45° FOV.
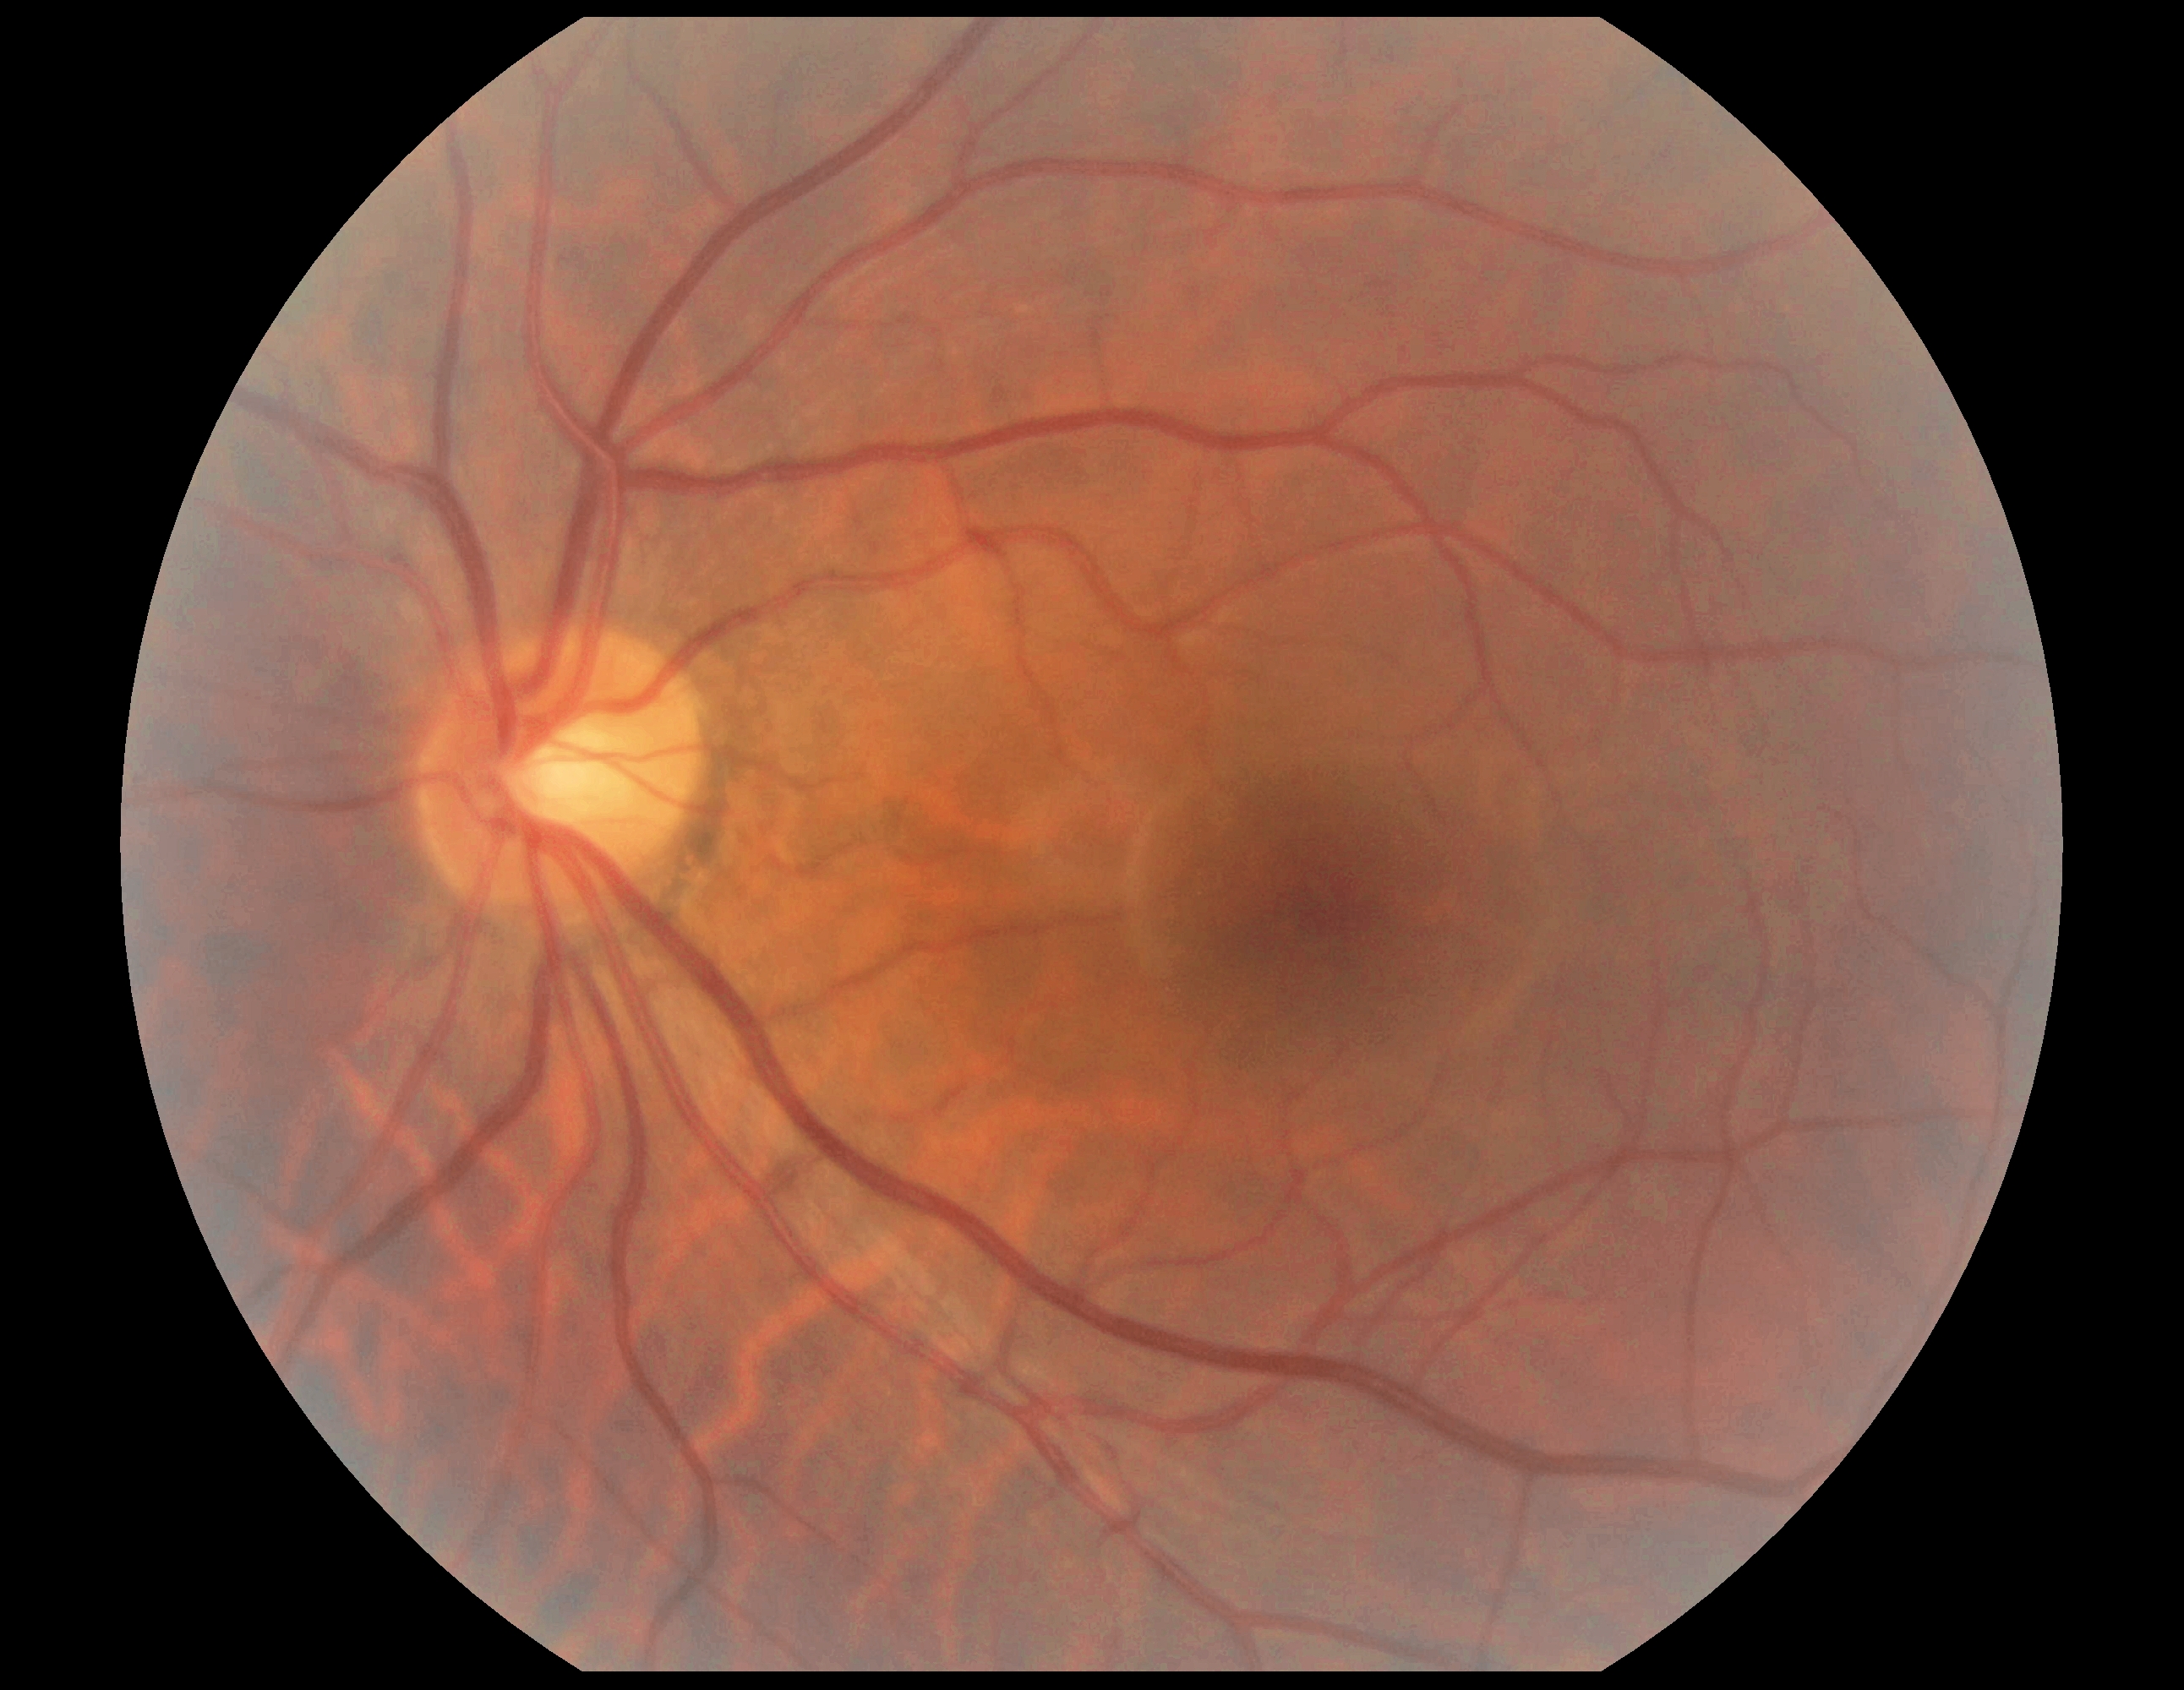 No DR findings.
Diabetic retinopathy is no apparent retinopathy (grade 0).